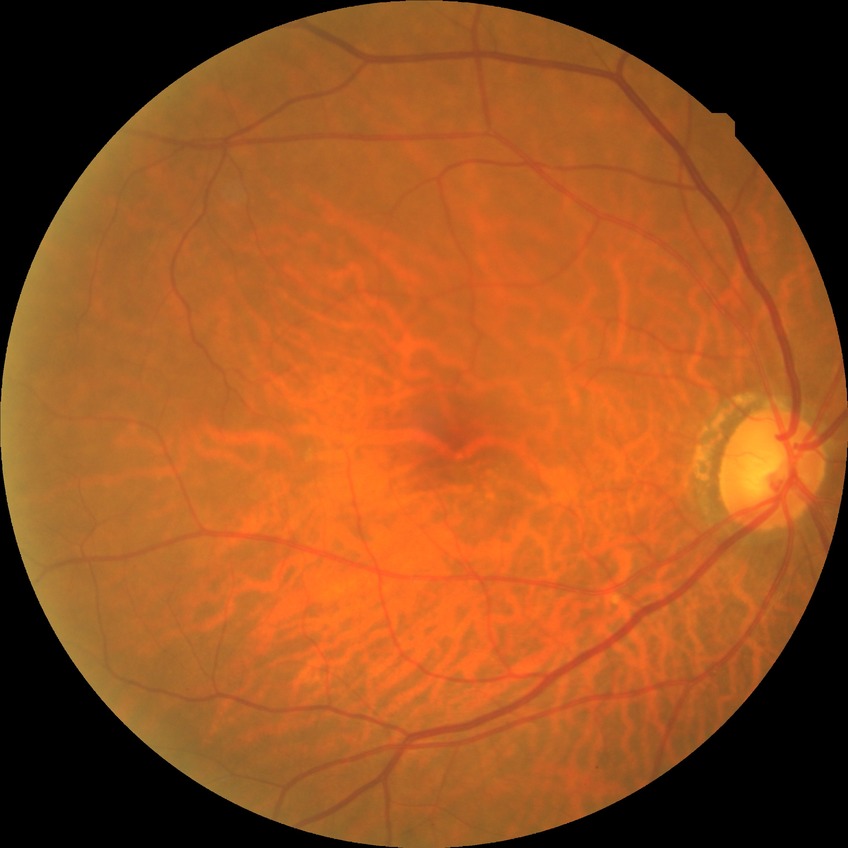

davis_grade: no diabetic retinopathy